Color fundus photograph: 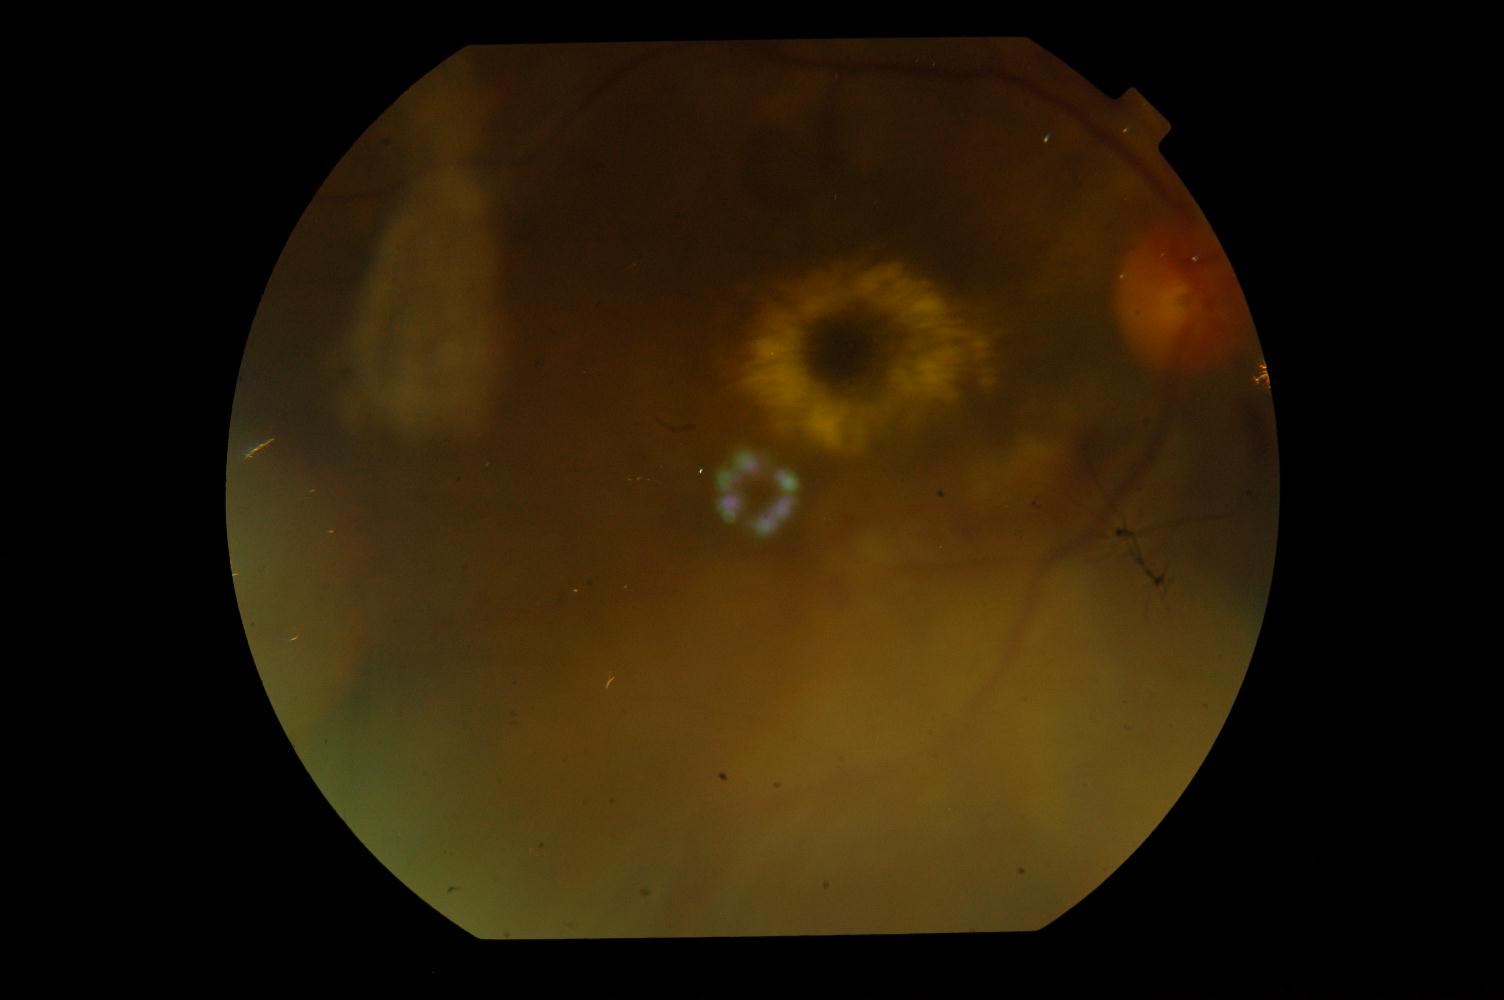 The image shows hypertensive retinopathy (HTN).